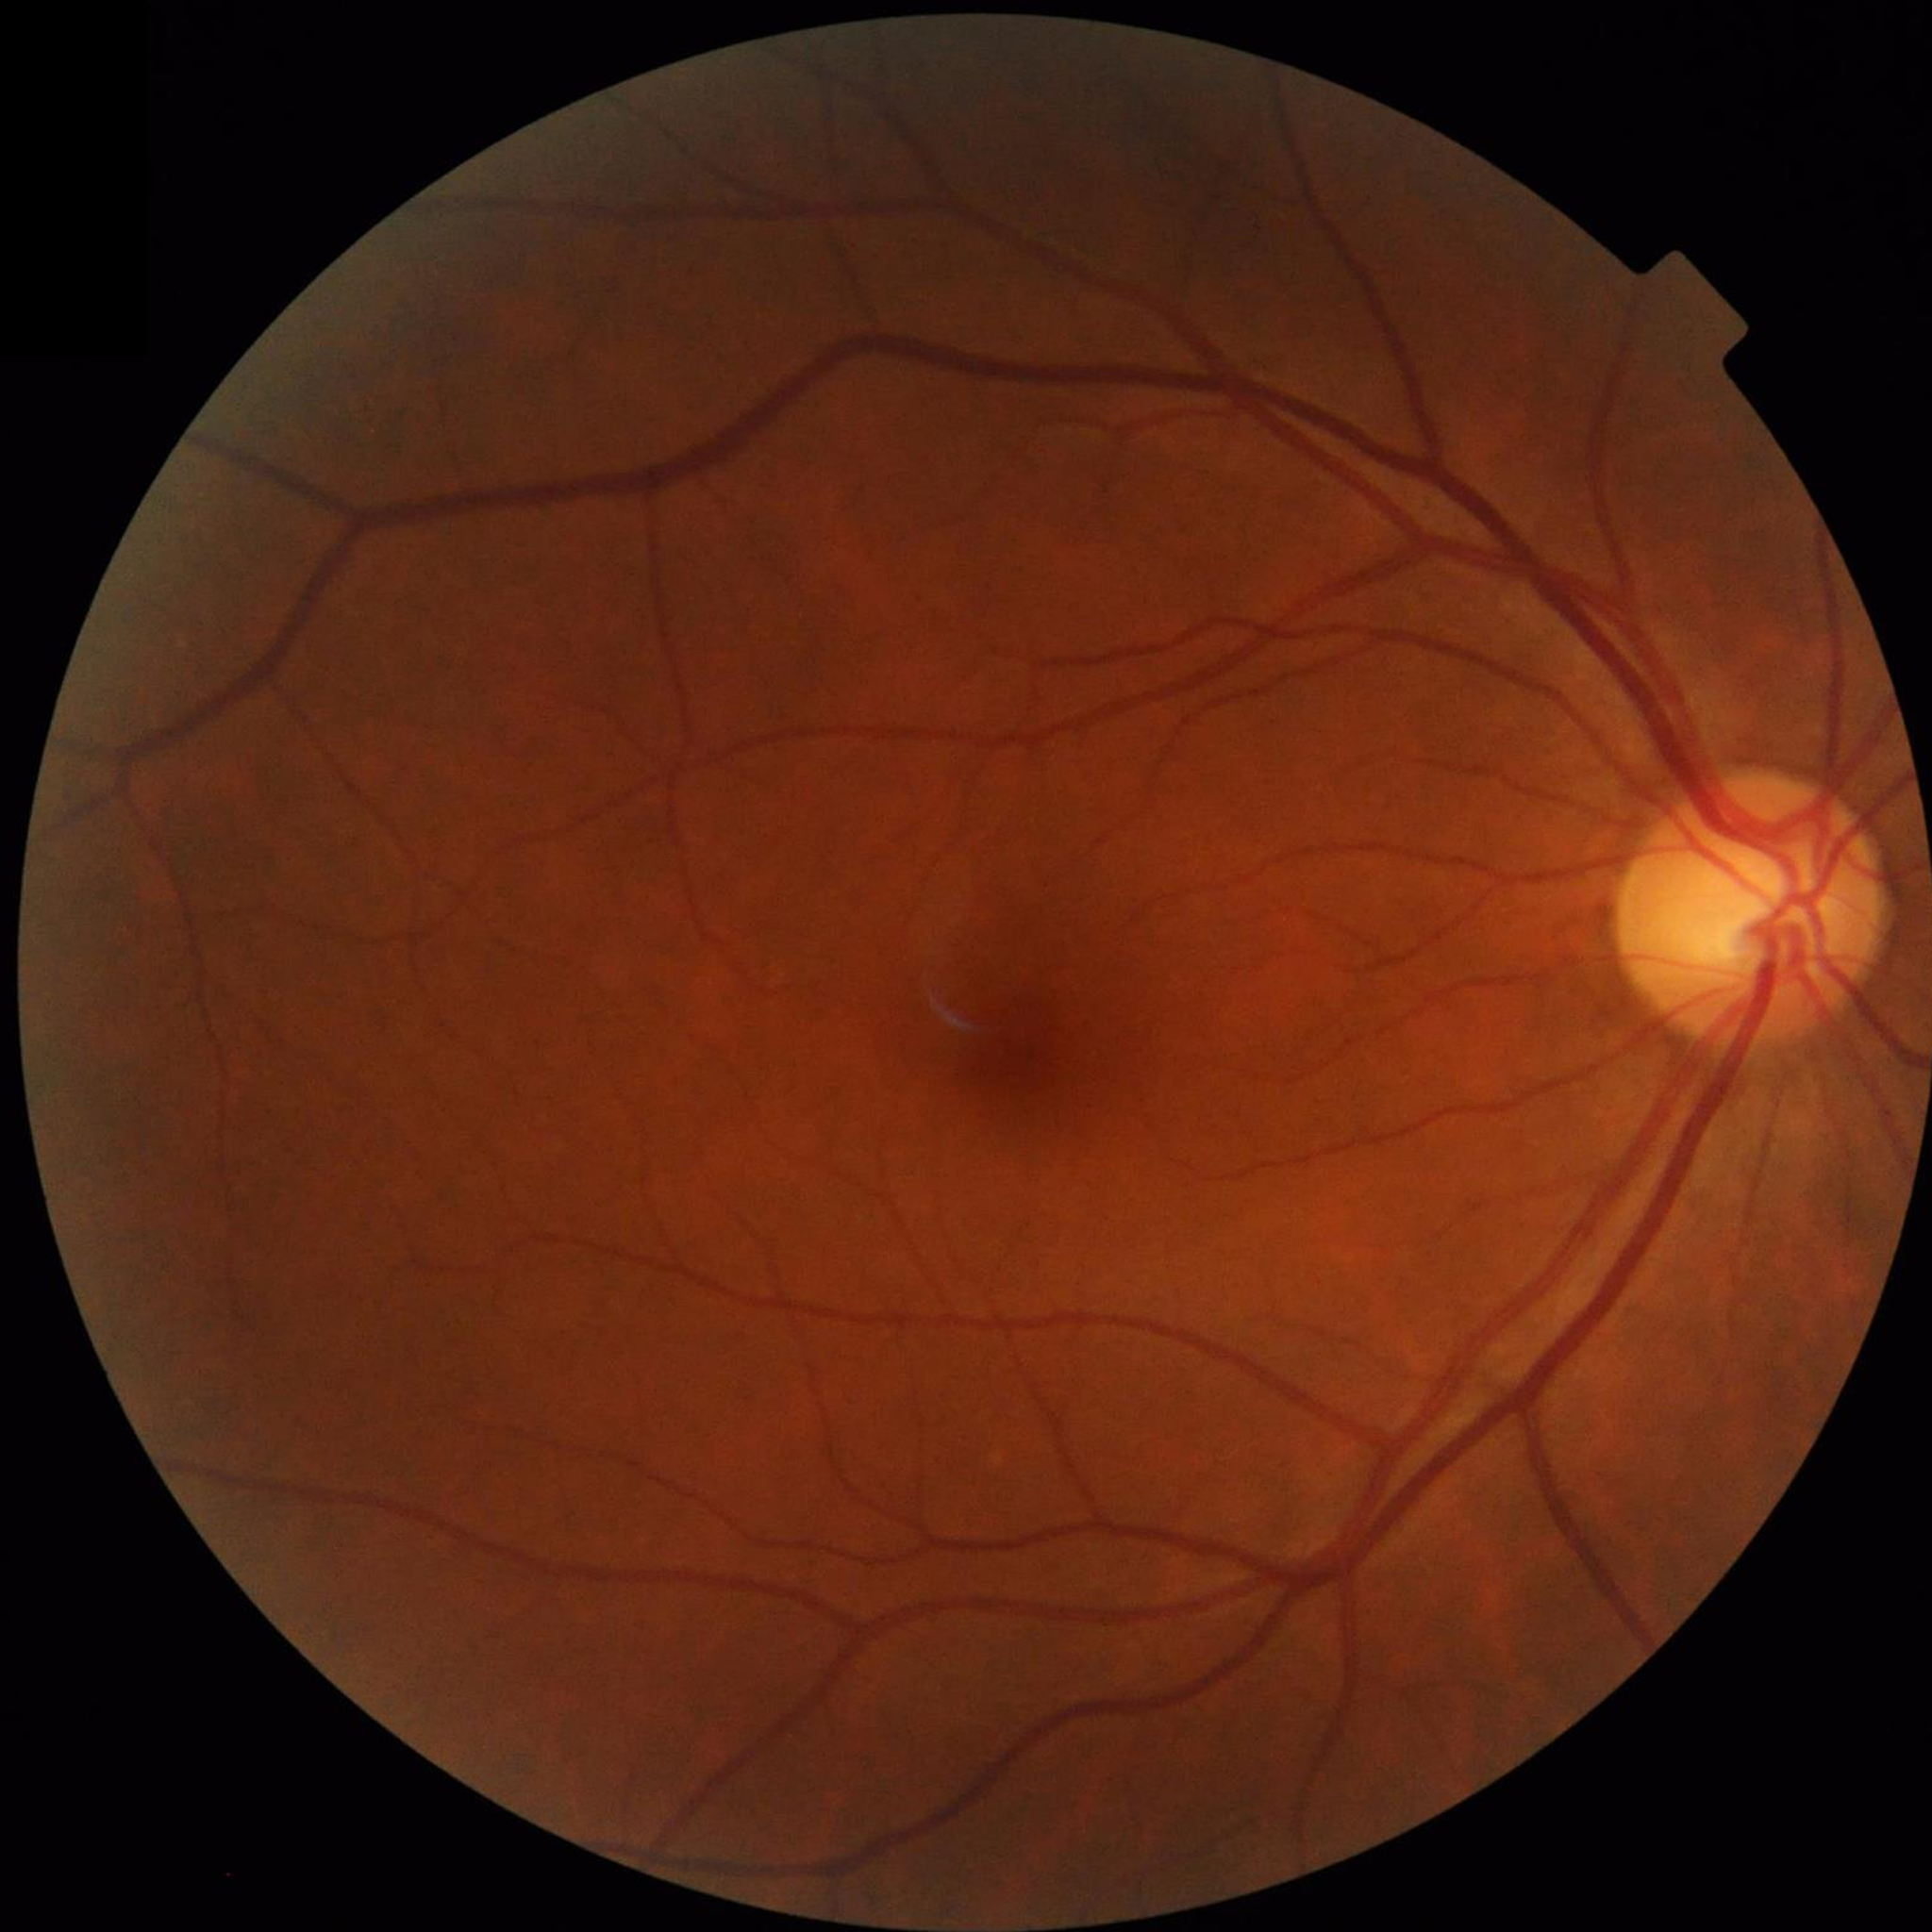

diagnosis: control (no AMD/DR/glaucoma)